Camera: NIDEK AFC-230. Diabetic retinopathy graded by the modified Davis classification. Posterior pole photograph:
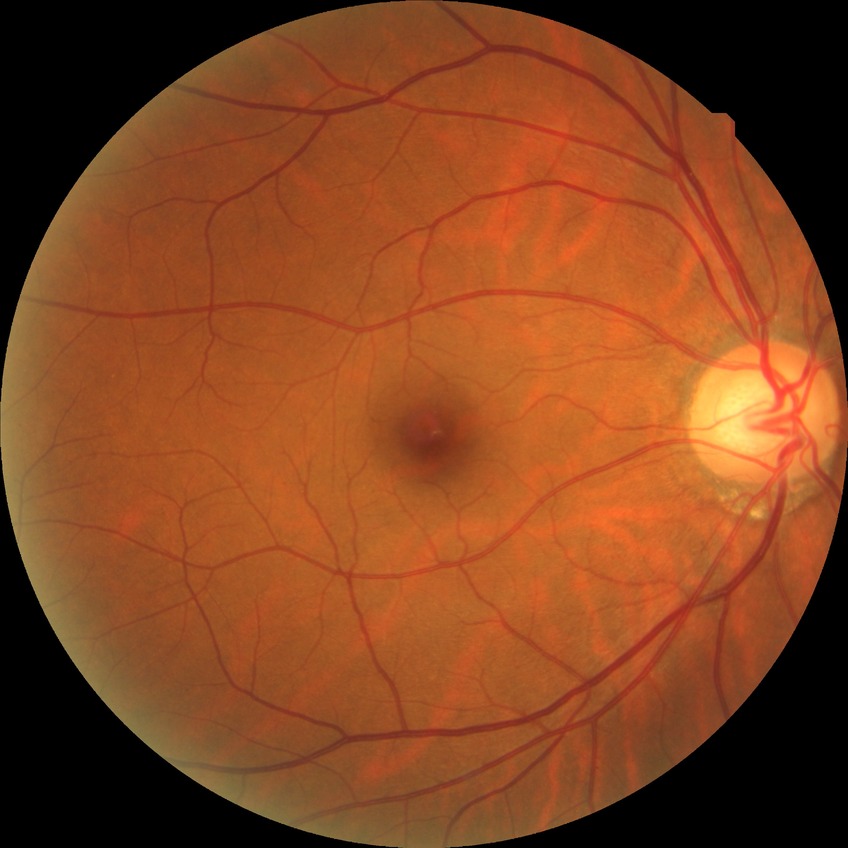

Diabetic retinopathy (DR): NDR (no diabetic retinopathy).